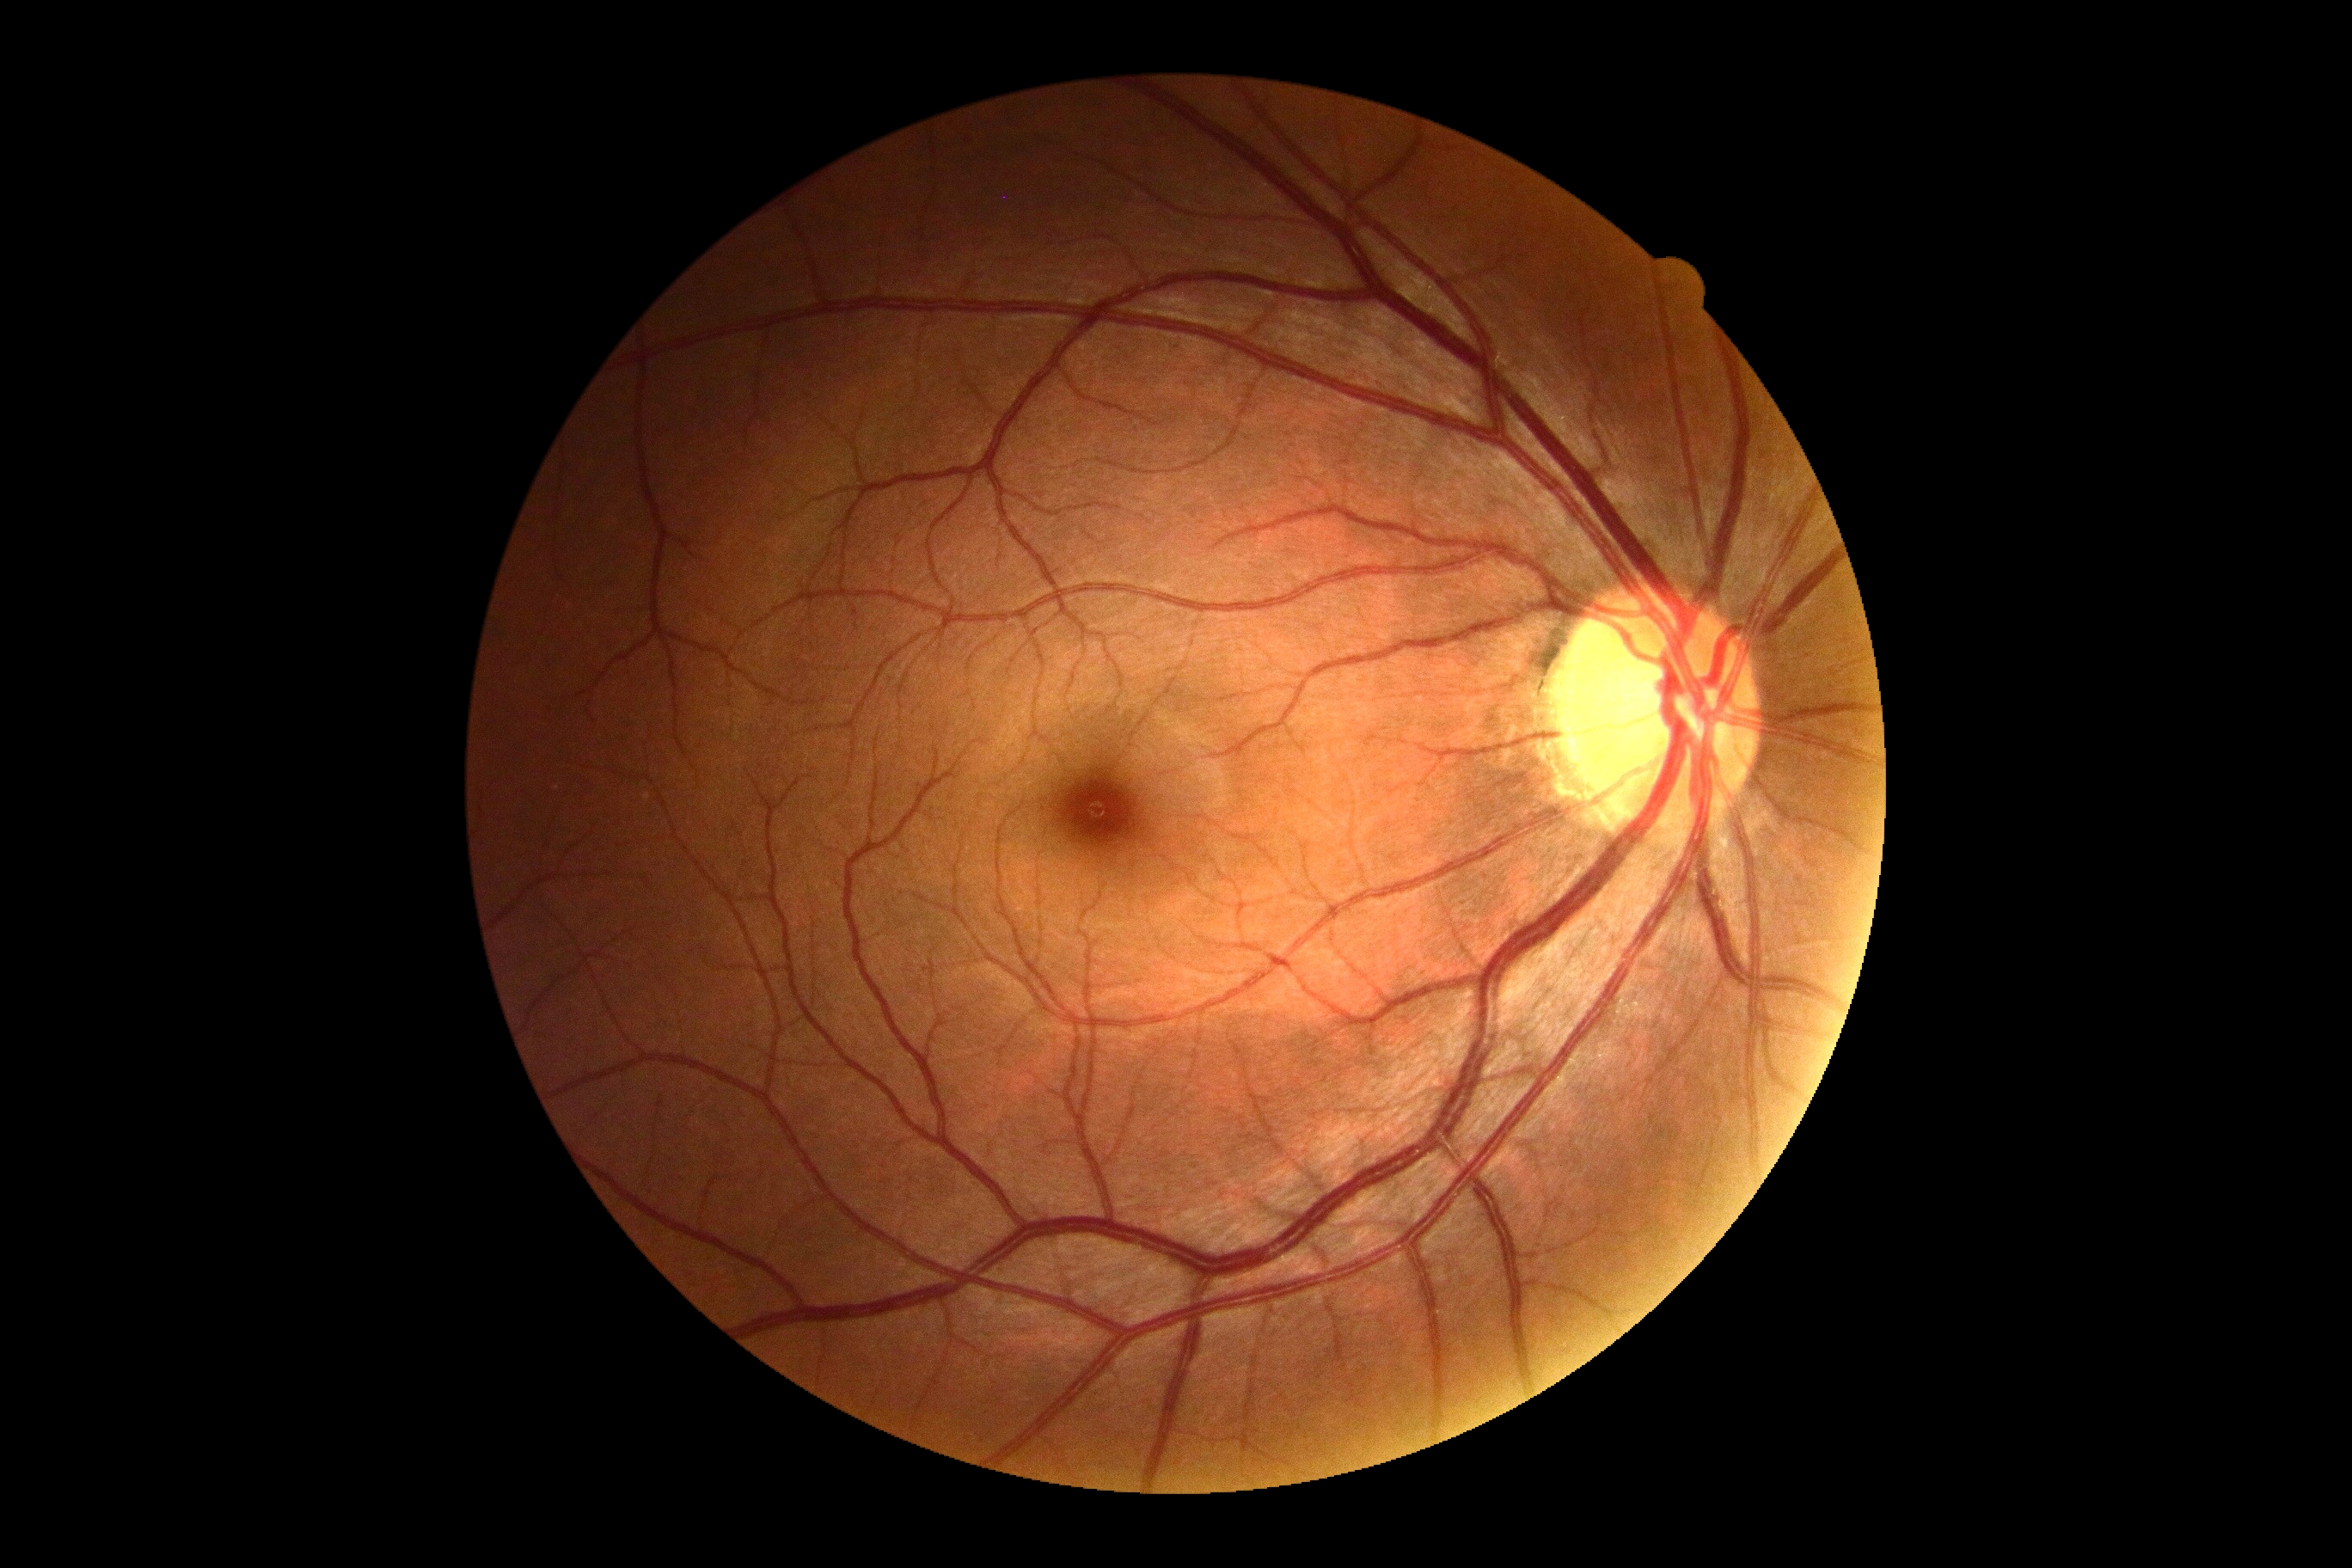 {
  "dr_impression": "negative for DR",
  "dr_grade": "0"
}